Color fundus image; image size 2228x1652; FOV: 50 degrees.
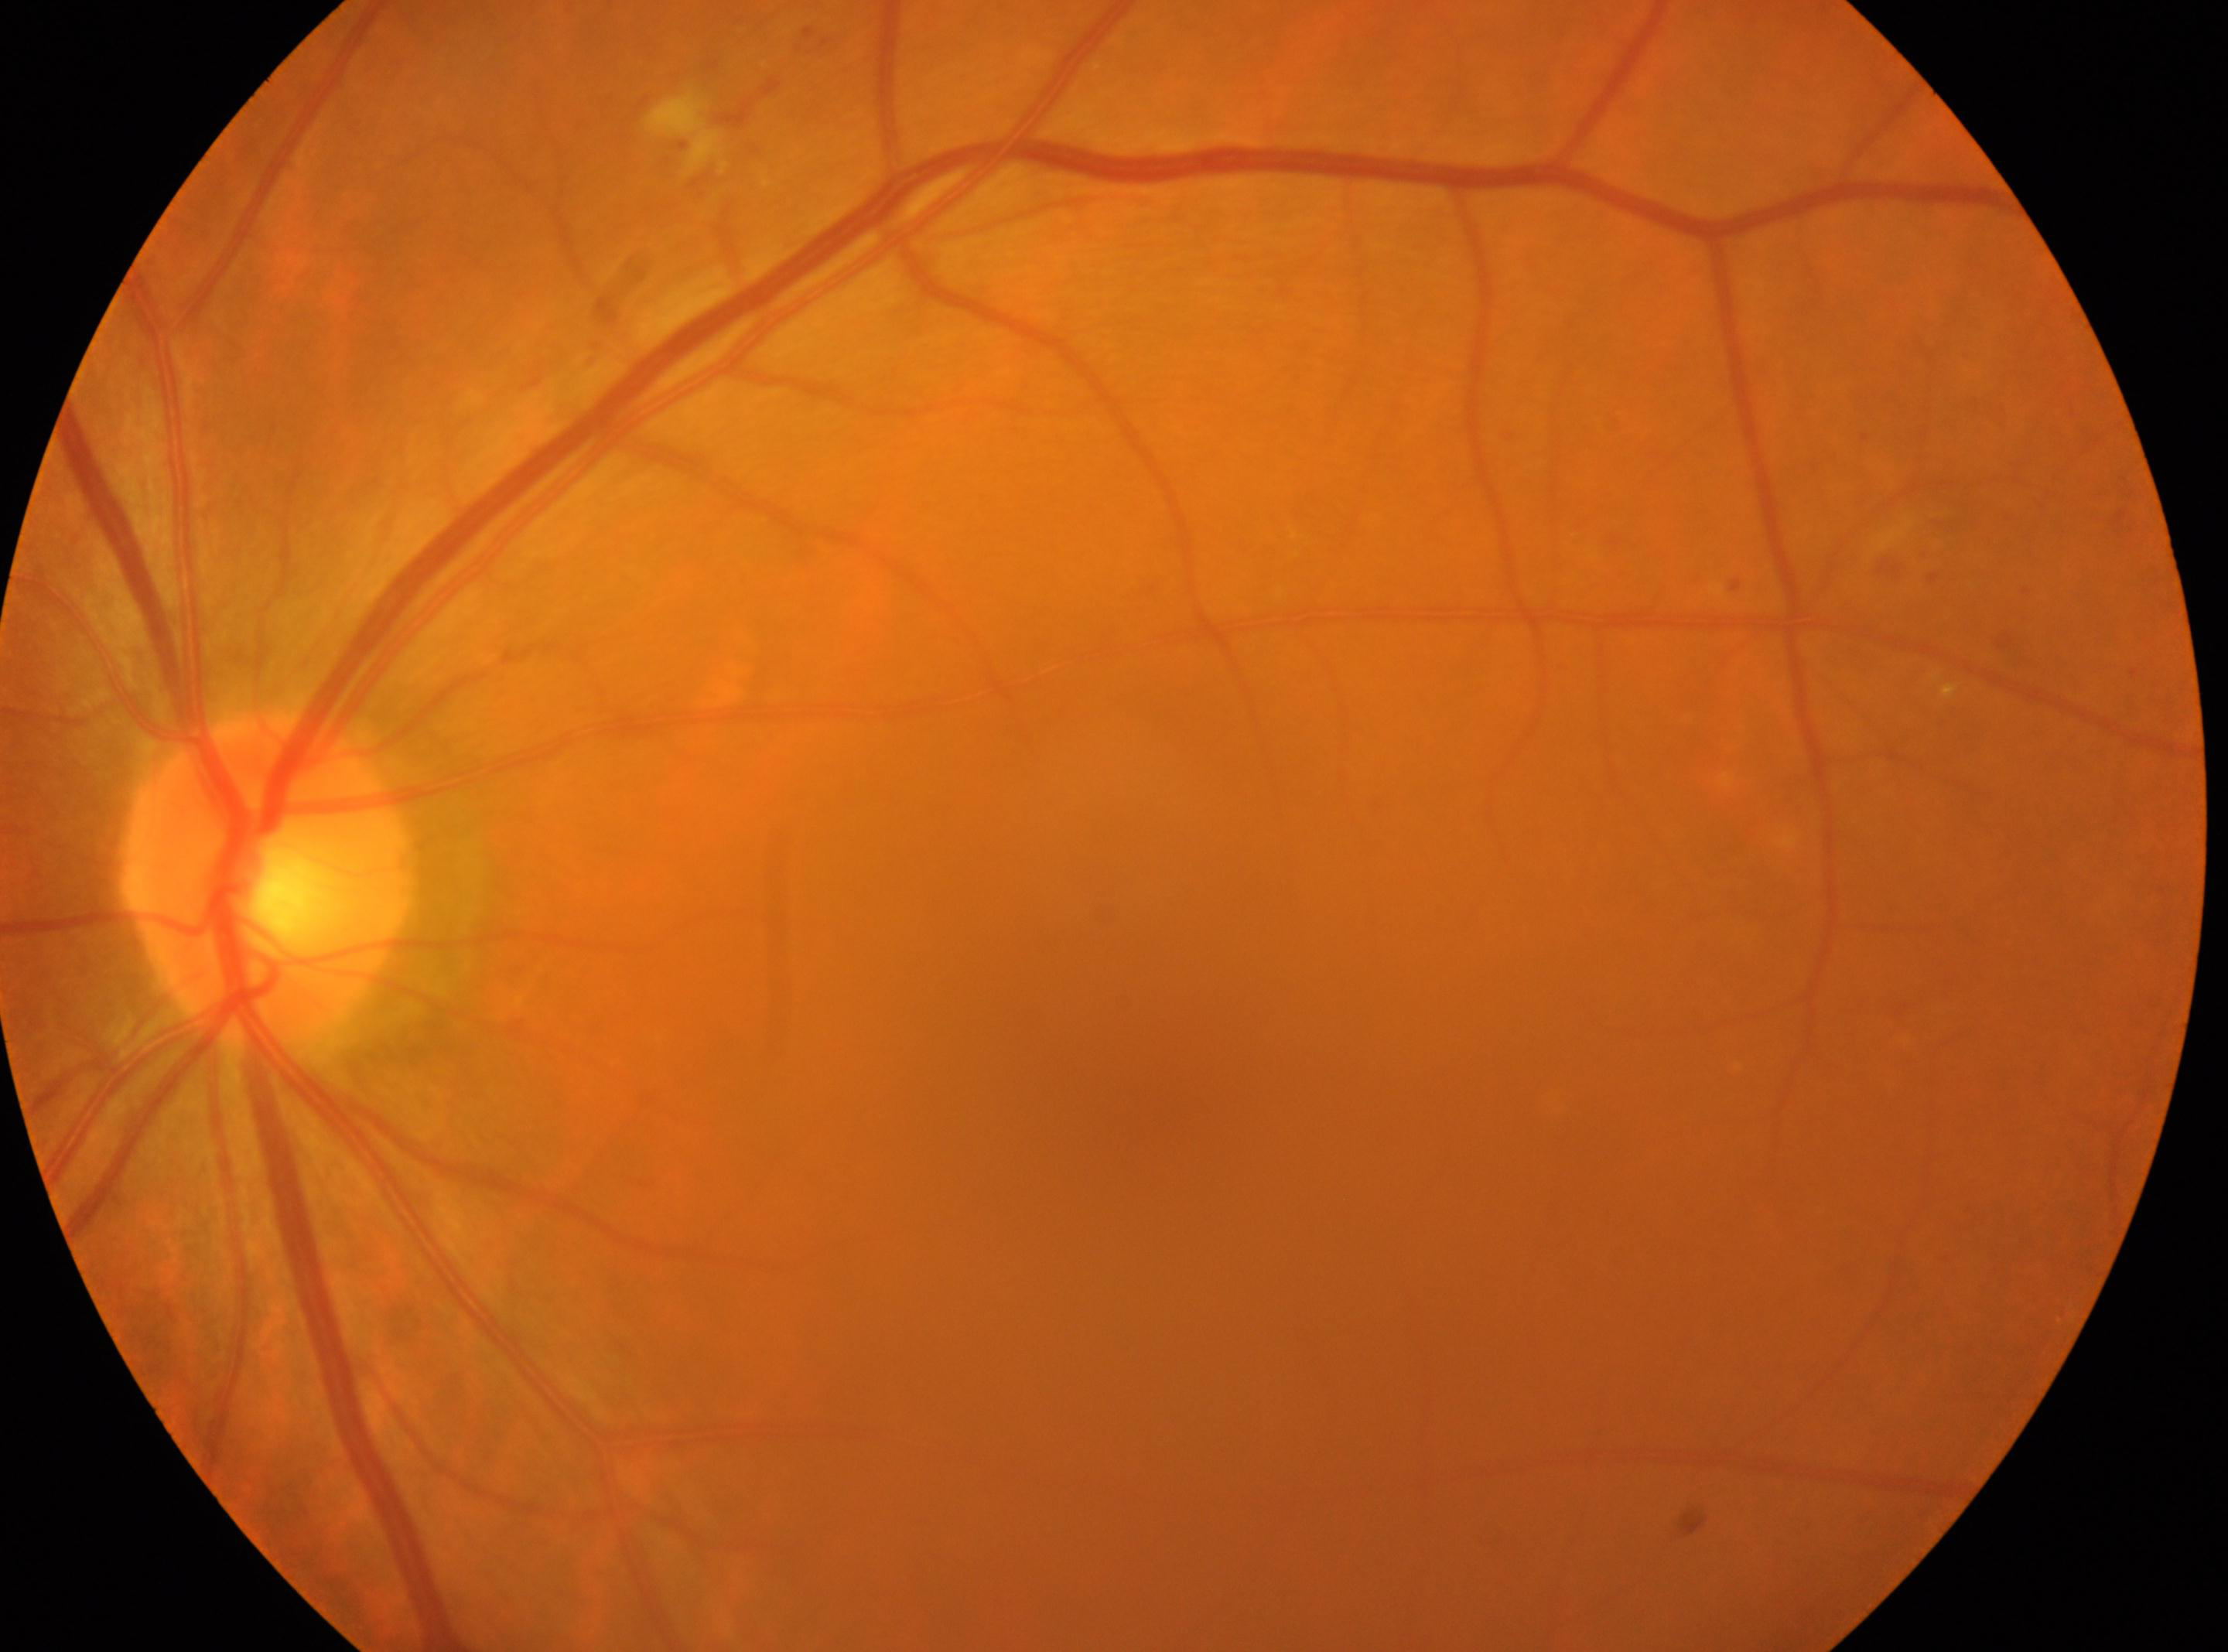

• laterality: left
• fovea: (1160,1049)
• diabetic retinopathy severity: grade 2 (moderate NPDR)
• optic disc center: (270,878)